Davis DR grading
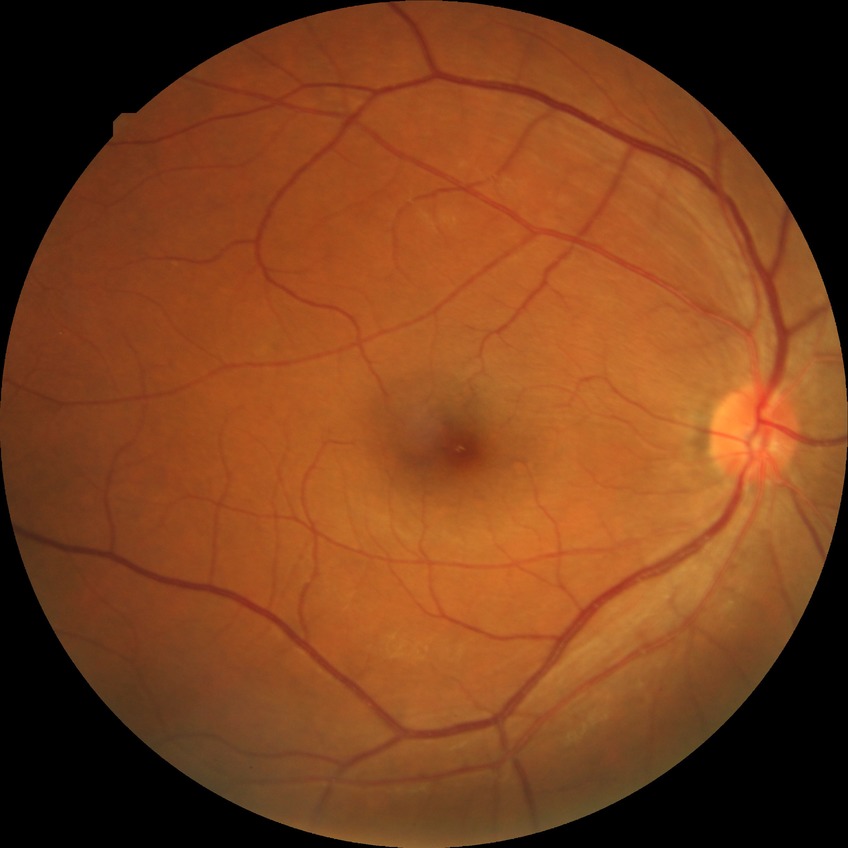
DR impression: negative for DR; DR grade: NDR.